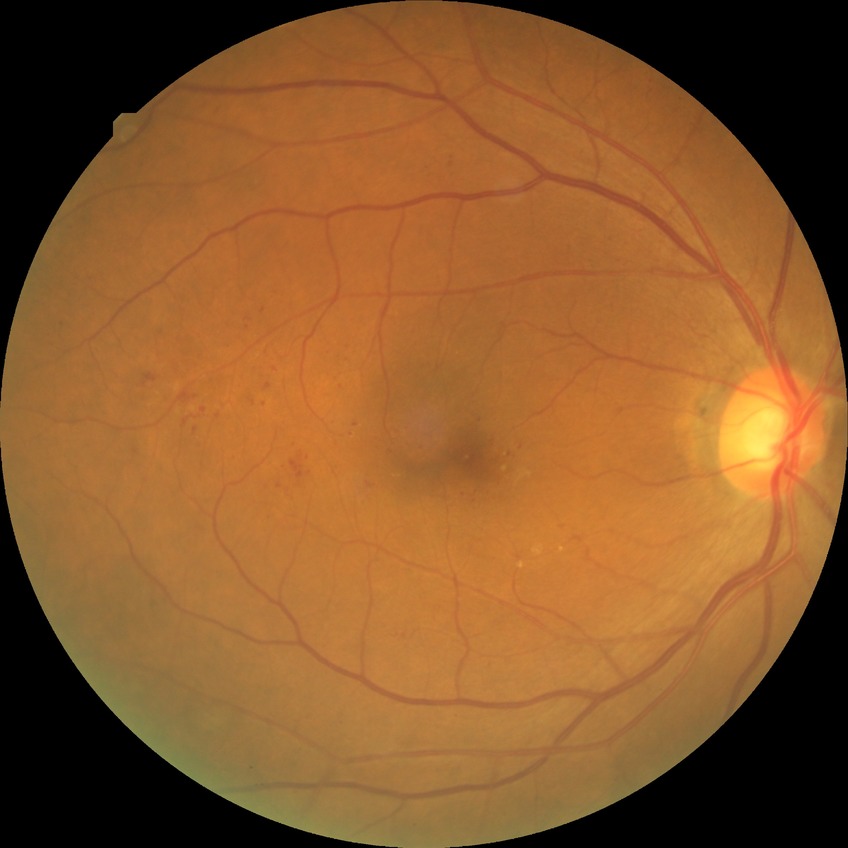

Davis stage: SDR.